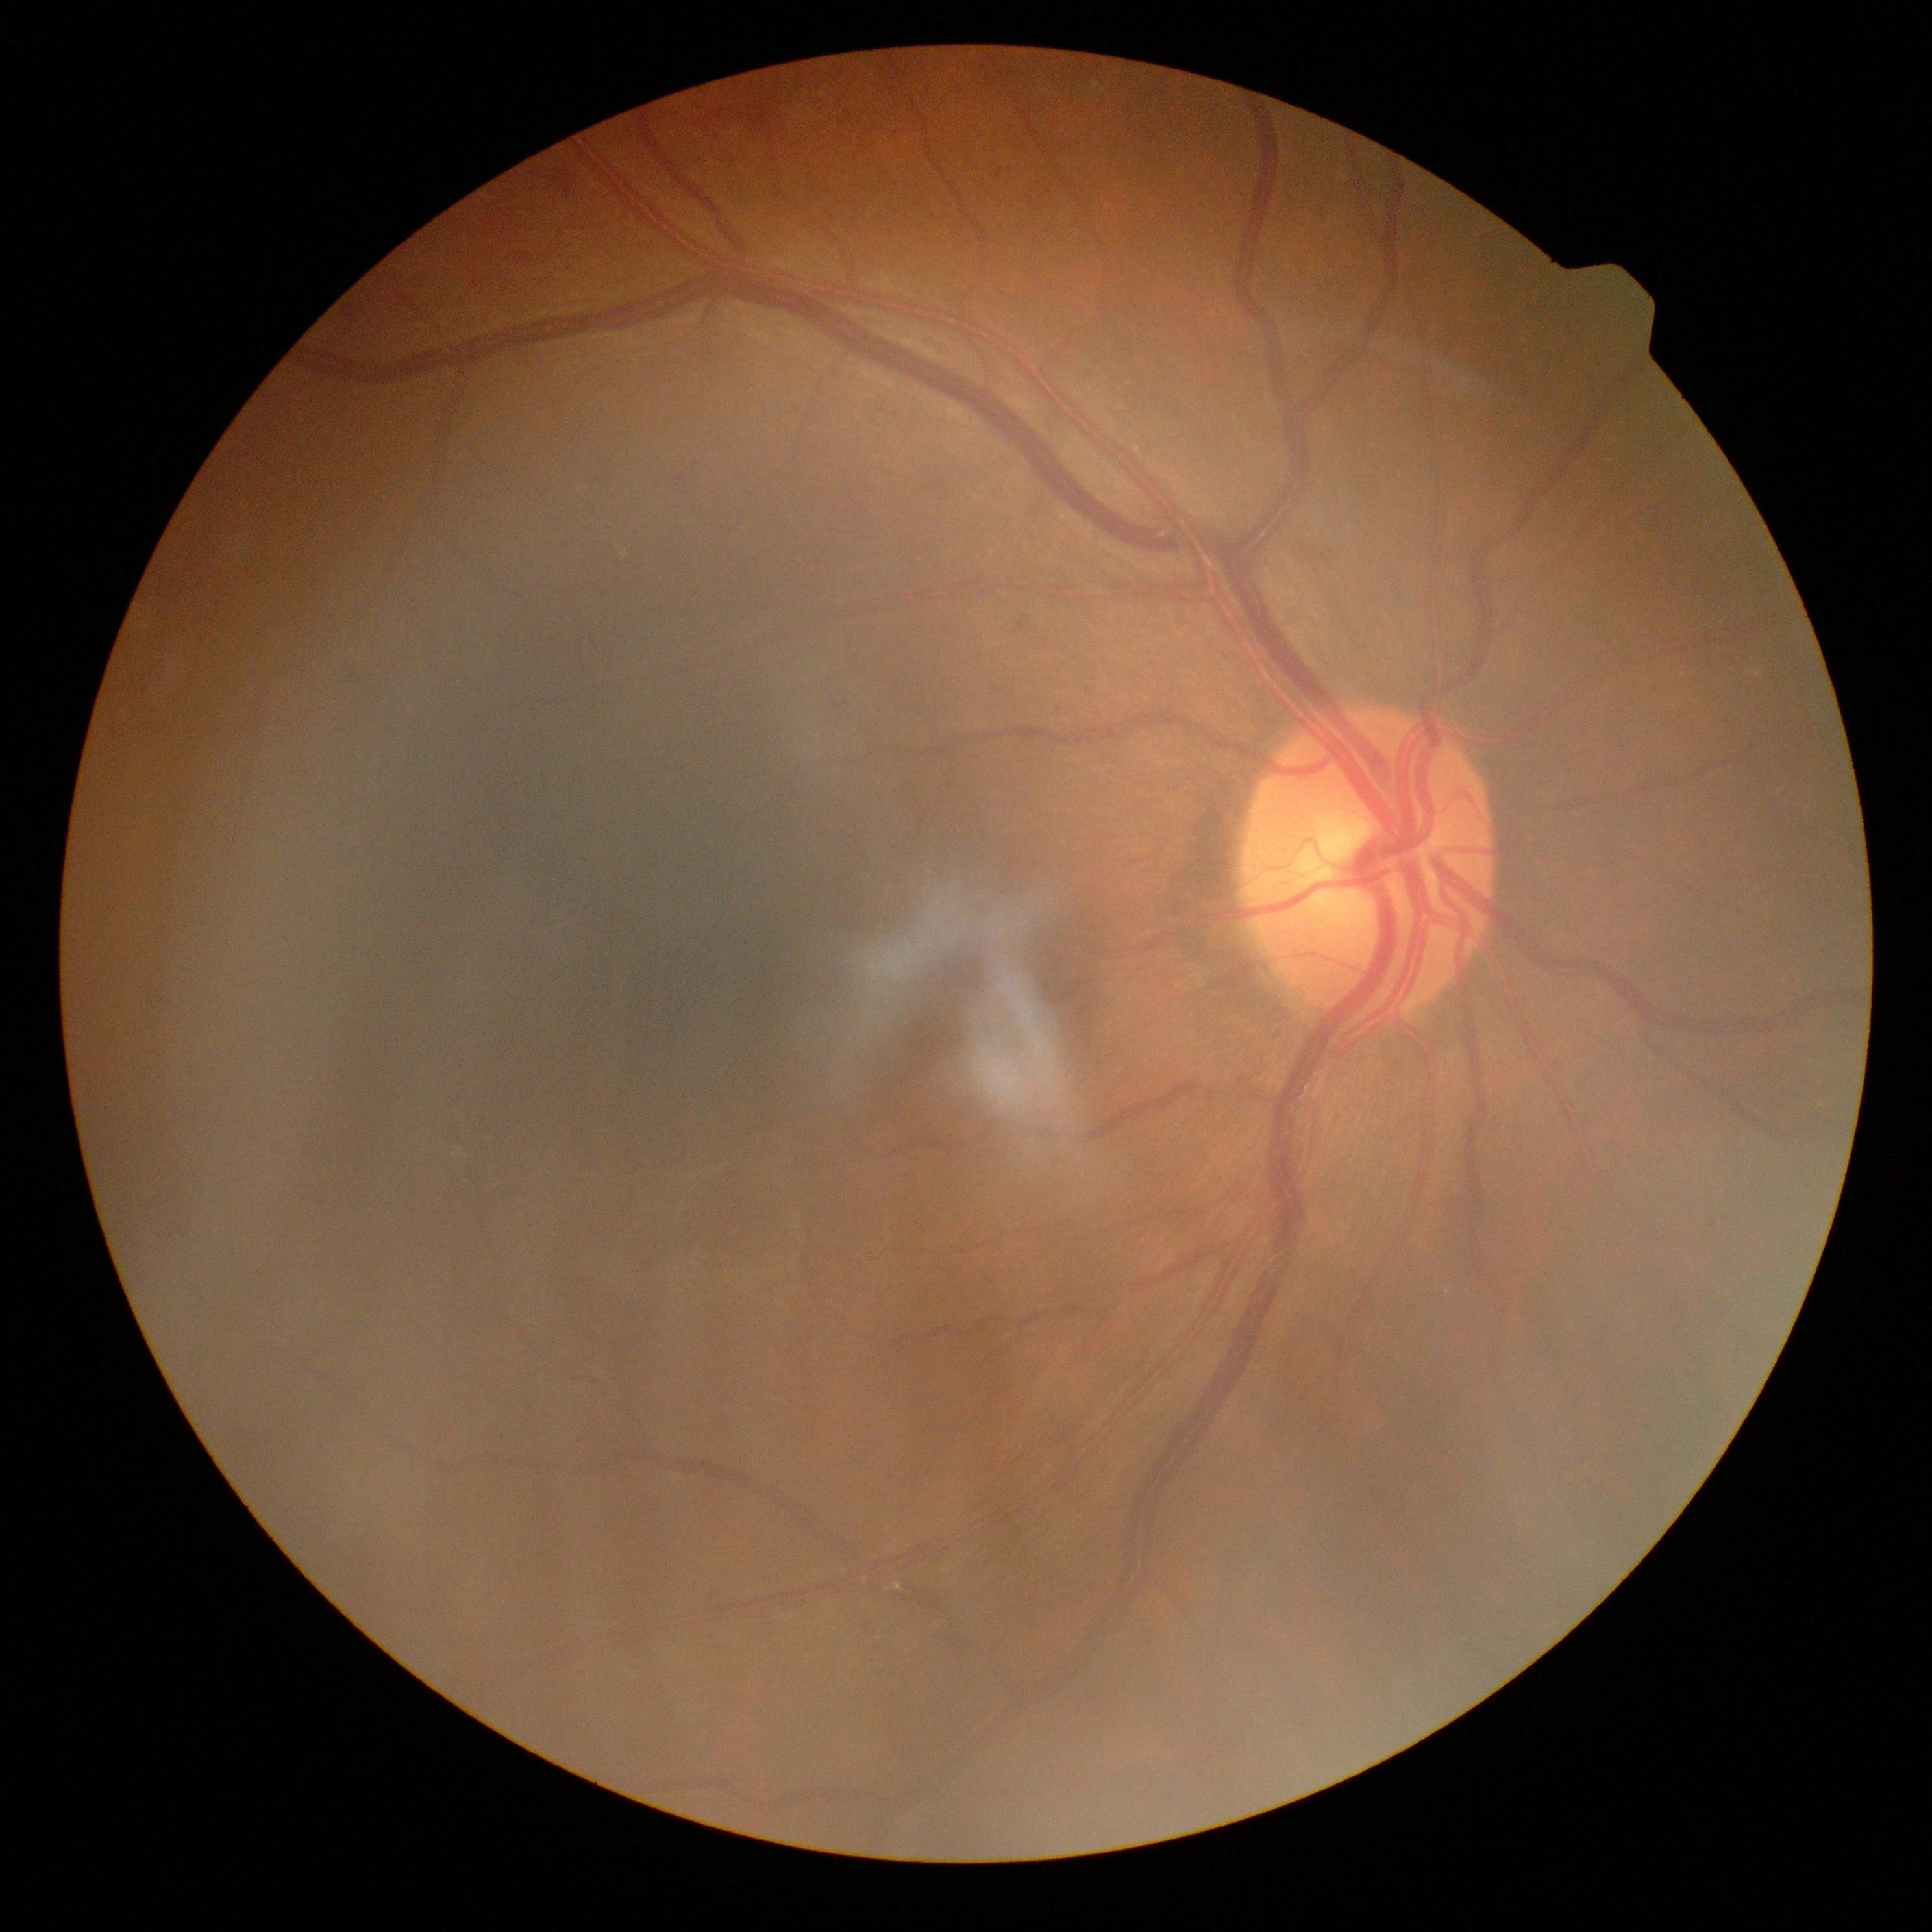

- DR grade — 2 (moderate NPDR)